2212x1659px, 45° FOV
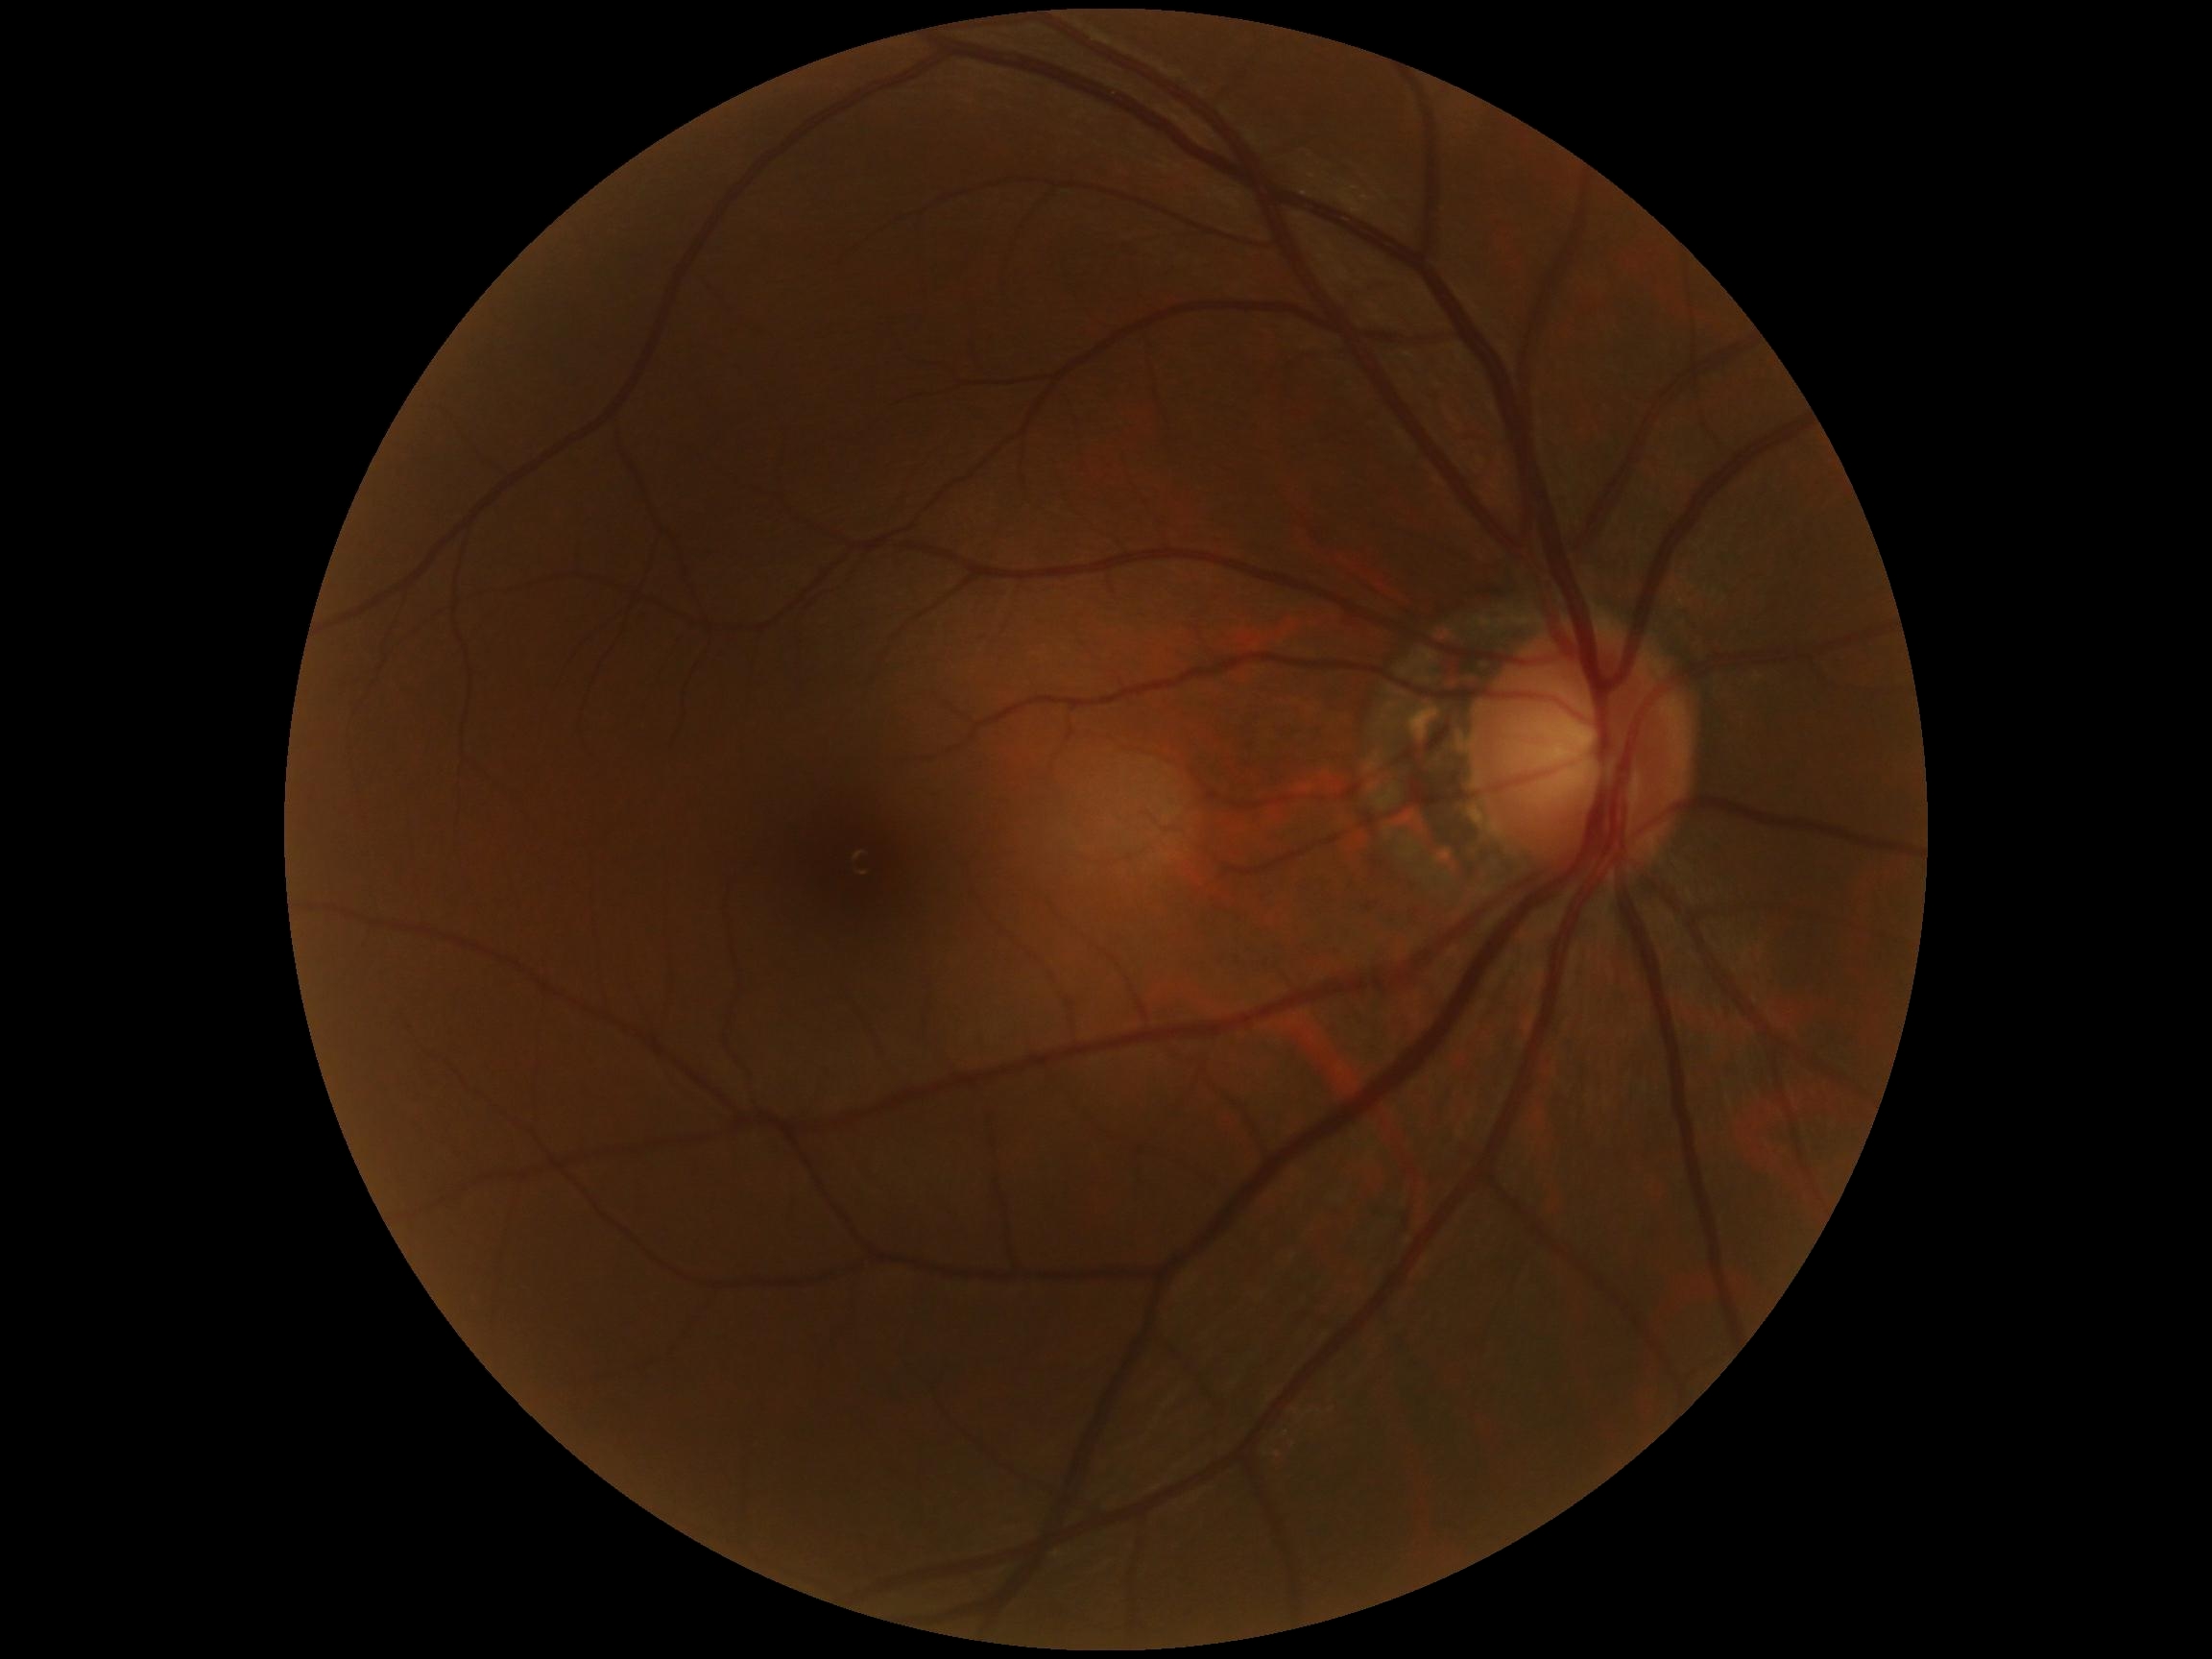
Annotations:
* DR grade — no apparent retinopathy (0)
* DR impression — no apparent DR